1536x1152, CFP.
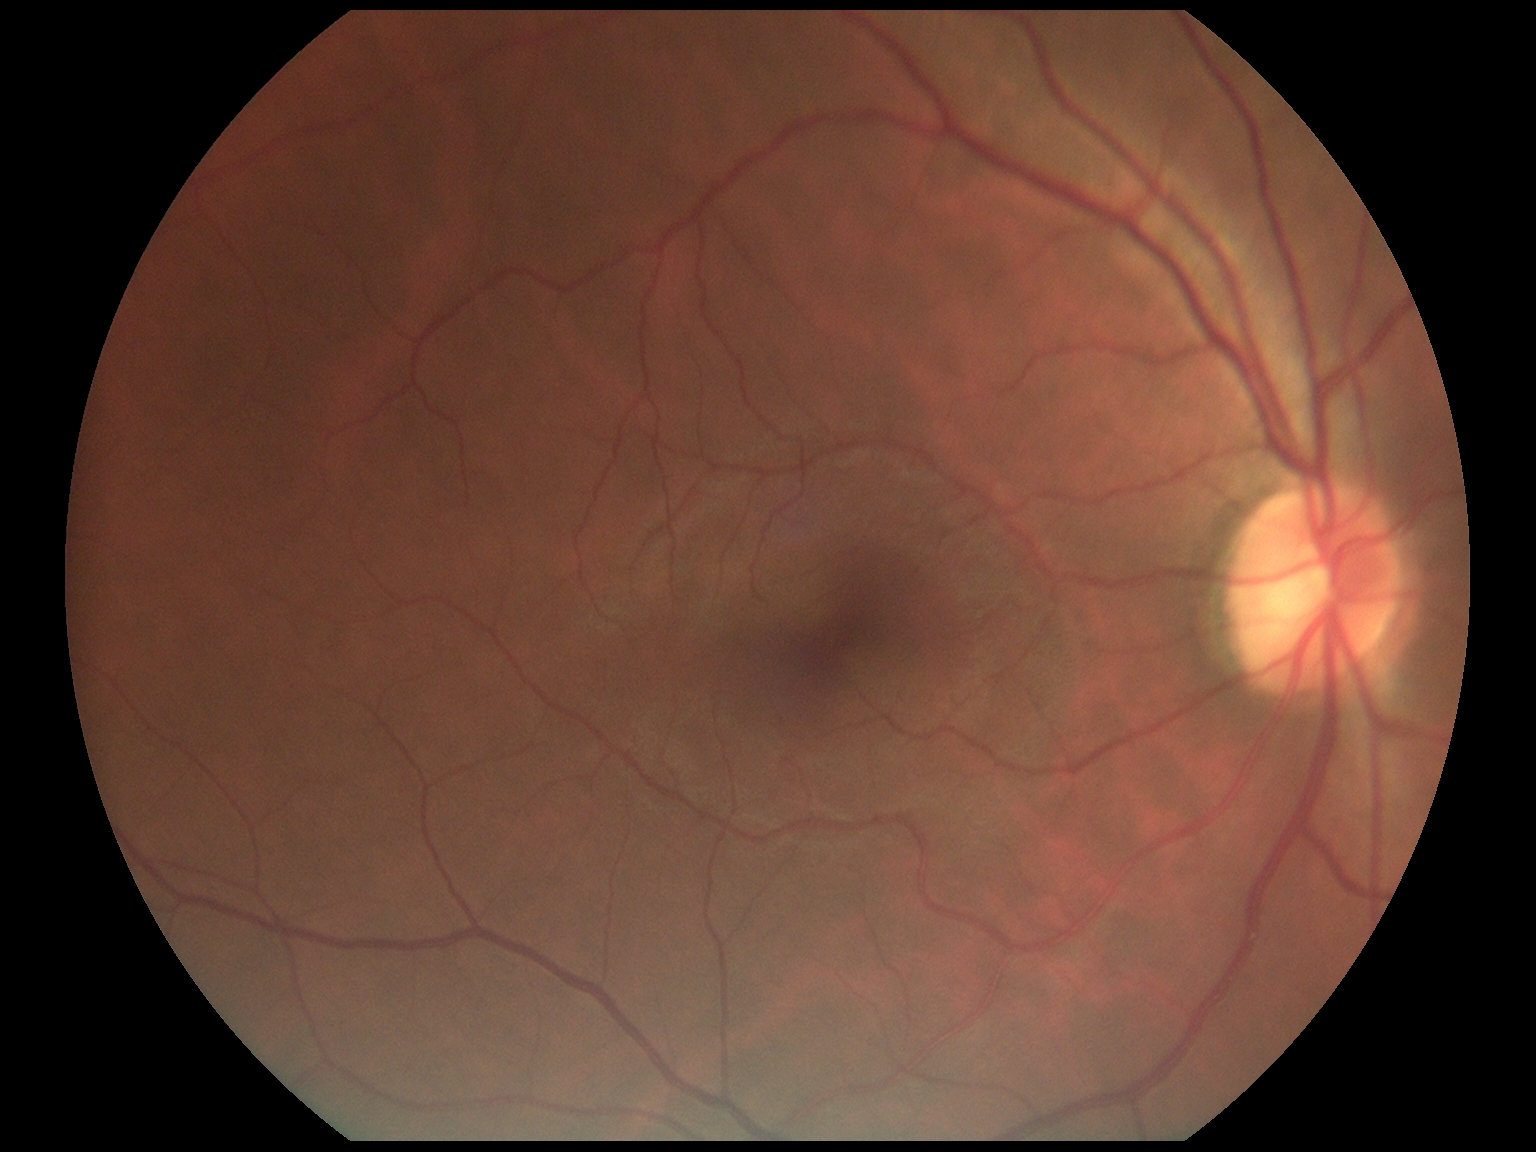
DR stage is grade 0 (no apparent retinopathy).